Wide-field contact fundus photograph of an infant — 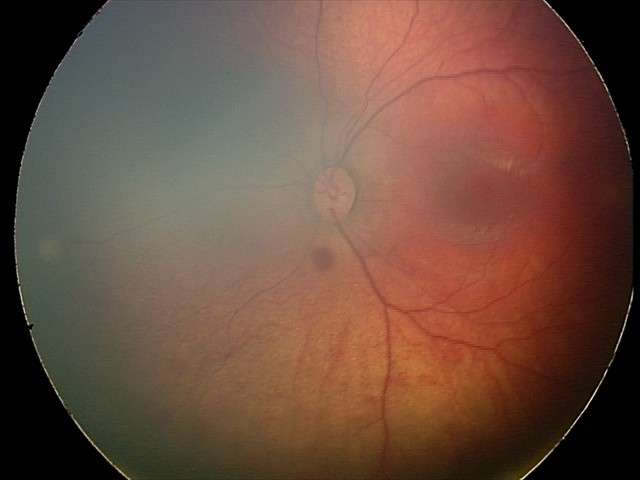

Diagnosis from this screening exam: retinal hemorrhages.